2346 x 1568 pixels, 45° FOV:
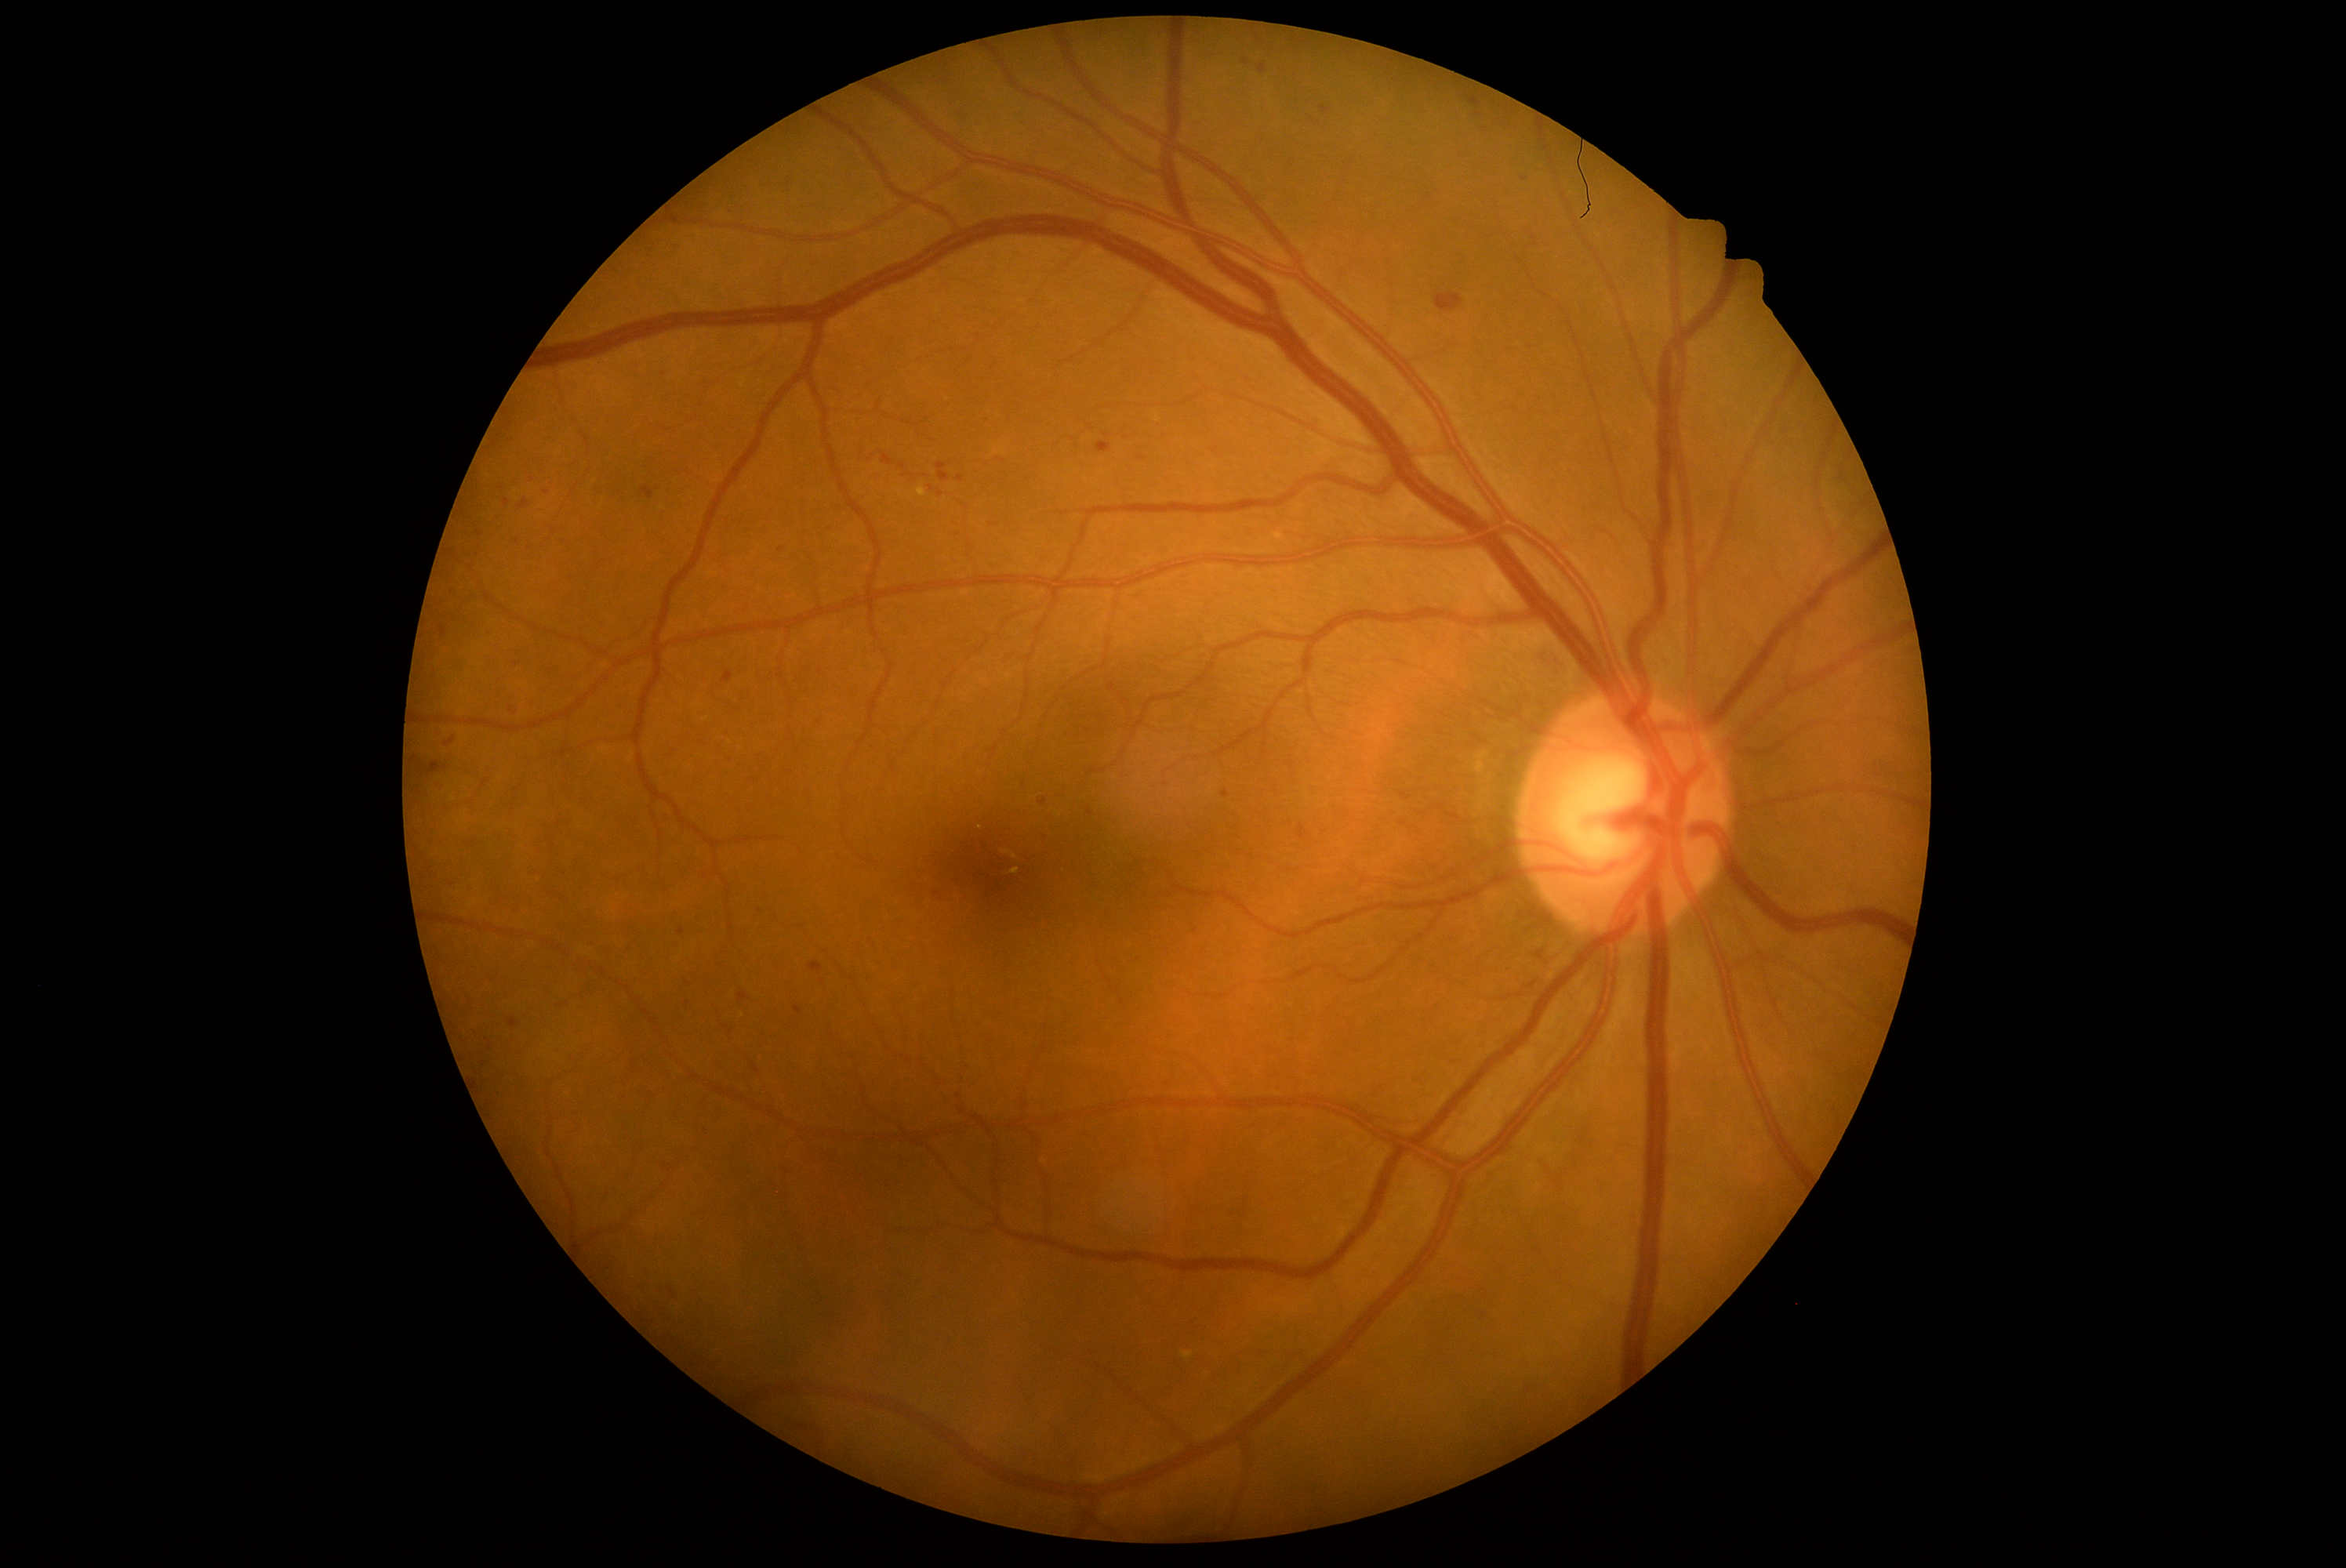 Diabetic retinopathy (DR) is grade 2 (moderate NPDR)
Lesions identified (partial list):
hemorrhages (HEs) (more not shown): bbox=[659, 811, 675, 824], bbox=[445, 733, 462, 750], bbox=[1222, 789, 1230, 799], bbox=[1320, 106, 1331, 114], bbox=[443, 877, 457, 893], bbox=[743, 804, 754, 815], bbox=[1086, 808, 1094, 816], bbox=[415, 757, 448, 775], bbox=[722, 755, 733, 764], bbox=[434, 780, 446, 793], bbox=[722, 672, 735, 683], bbox=[504, 499, 510, 507]
Small HEs near pt(545, 492), pt(1214, 452), pt(1196, 932), pt(931, 487), pt(822, 982), pt(993, 524)